UWF retinal mosaic, 200° field of view, 1924 x 1556 pixels: 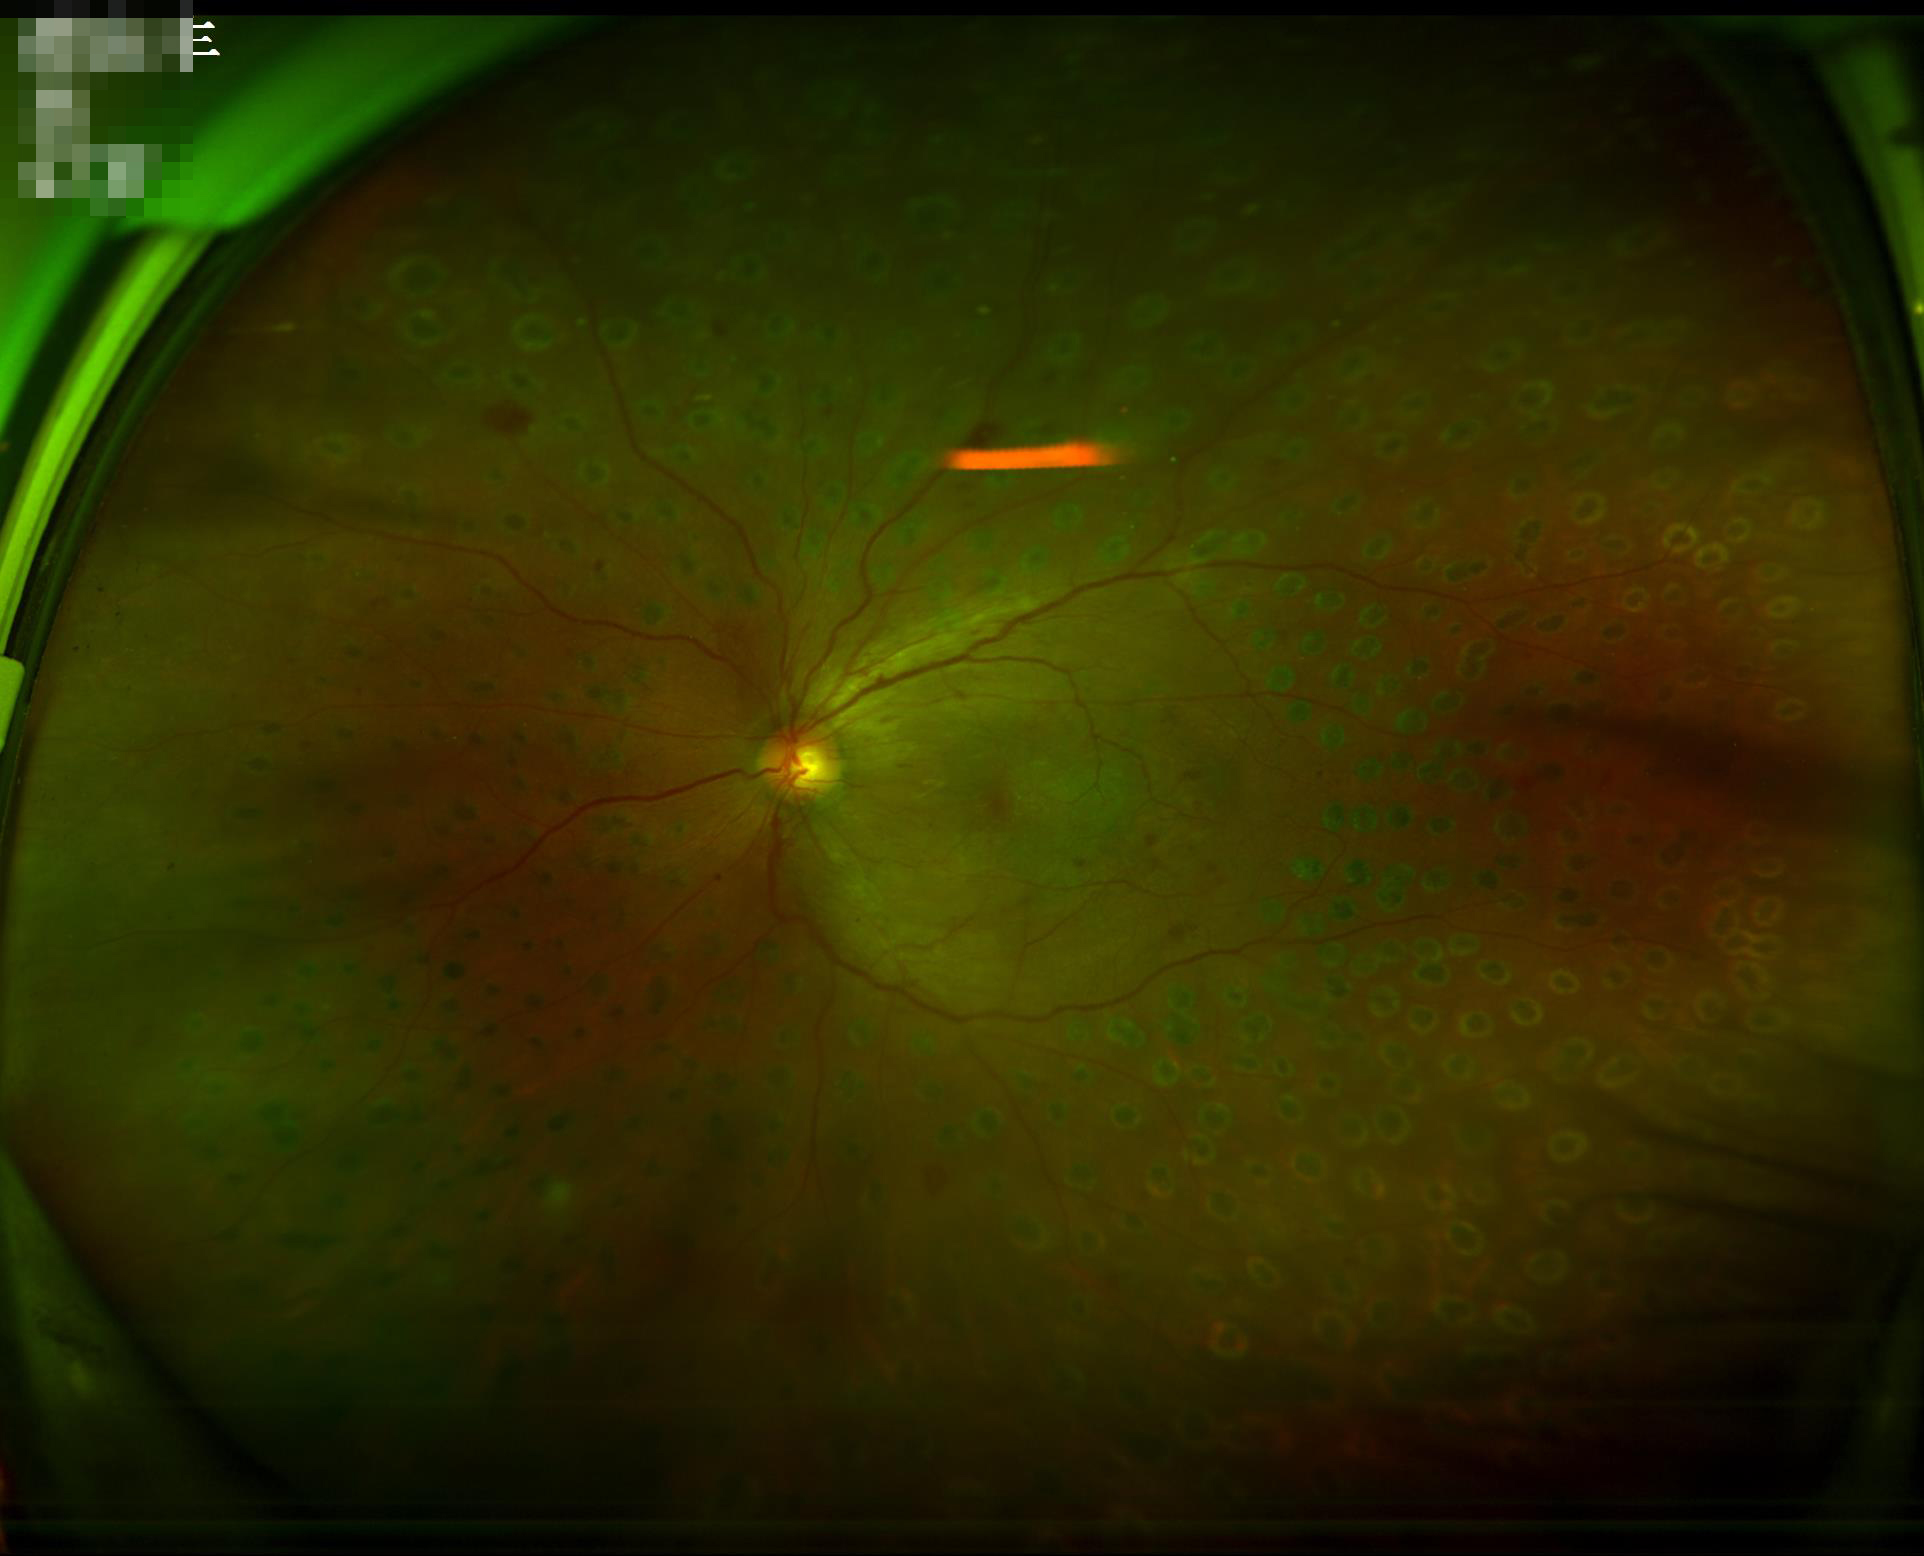

Poor illumination with uneven exposure. Overall image quality is good. The image is clear. Good dynamic range.